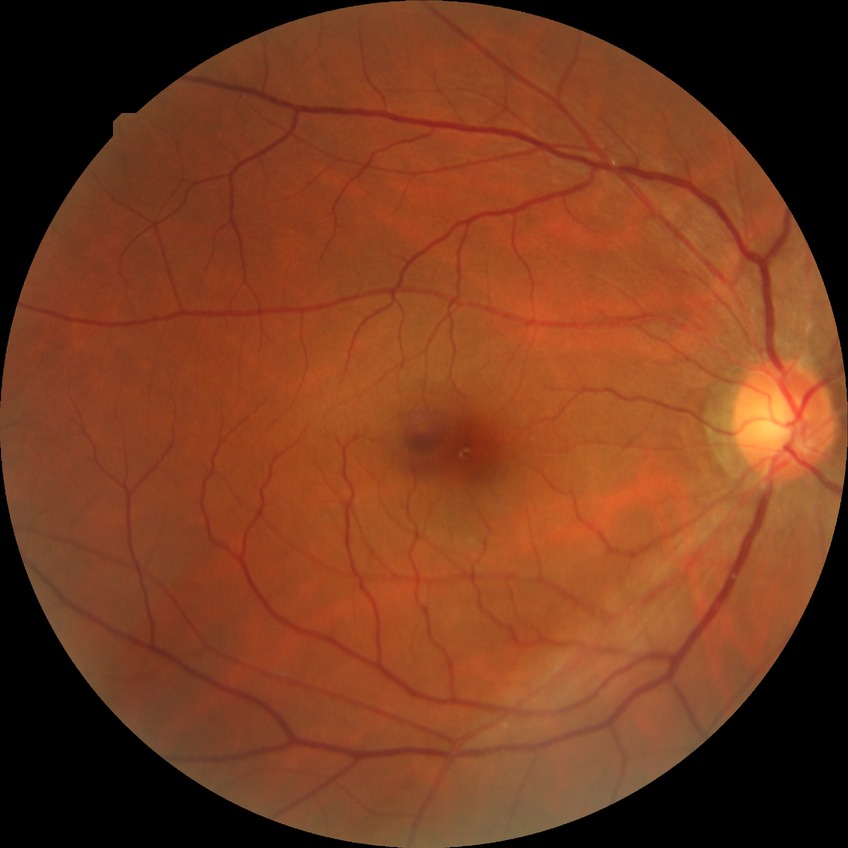

diabetic retinopathy (DR) = no diabetic retinopathy (NDR)